Davis DR grading.
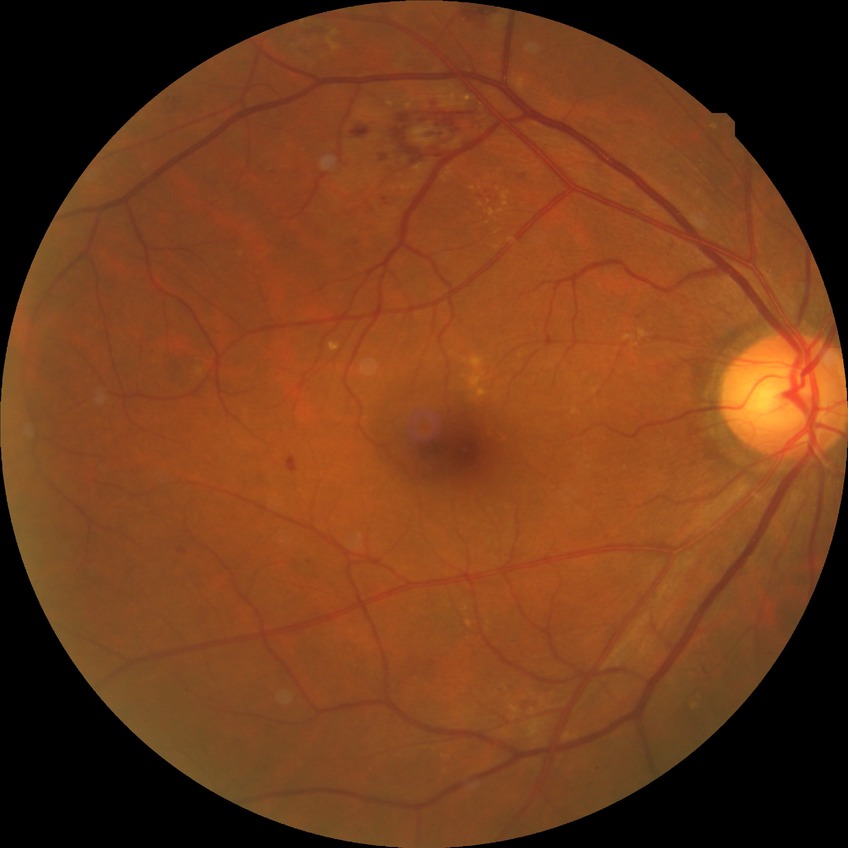

Retinopathy stage is simple diabetic retinopathy.